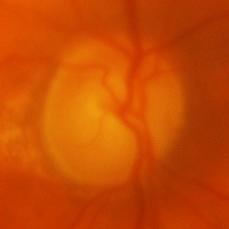

Glaucomatous optic neuropathy.